NIDEK AFC-230, 45-degree field of view, nonmydriatic fundus photograph, image size 848x848:
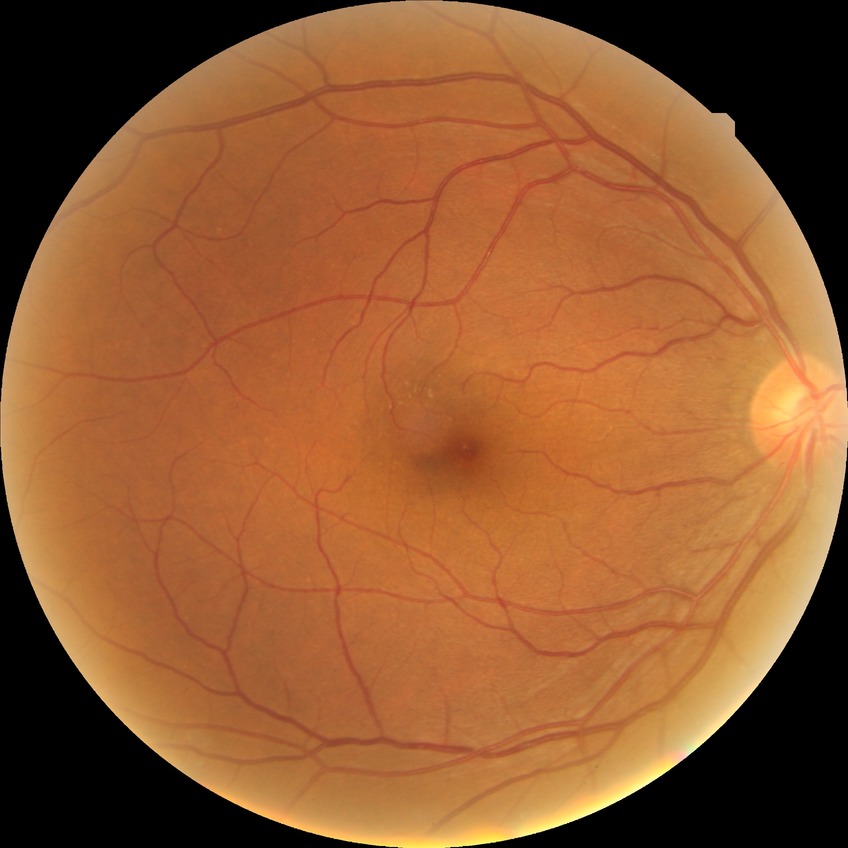

No DR findings.
Davis stage is NDR.